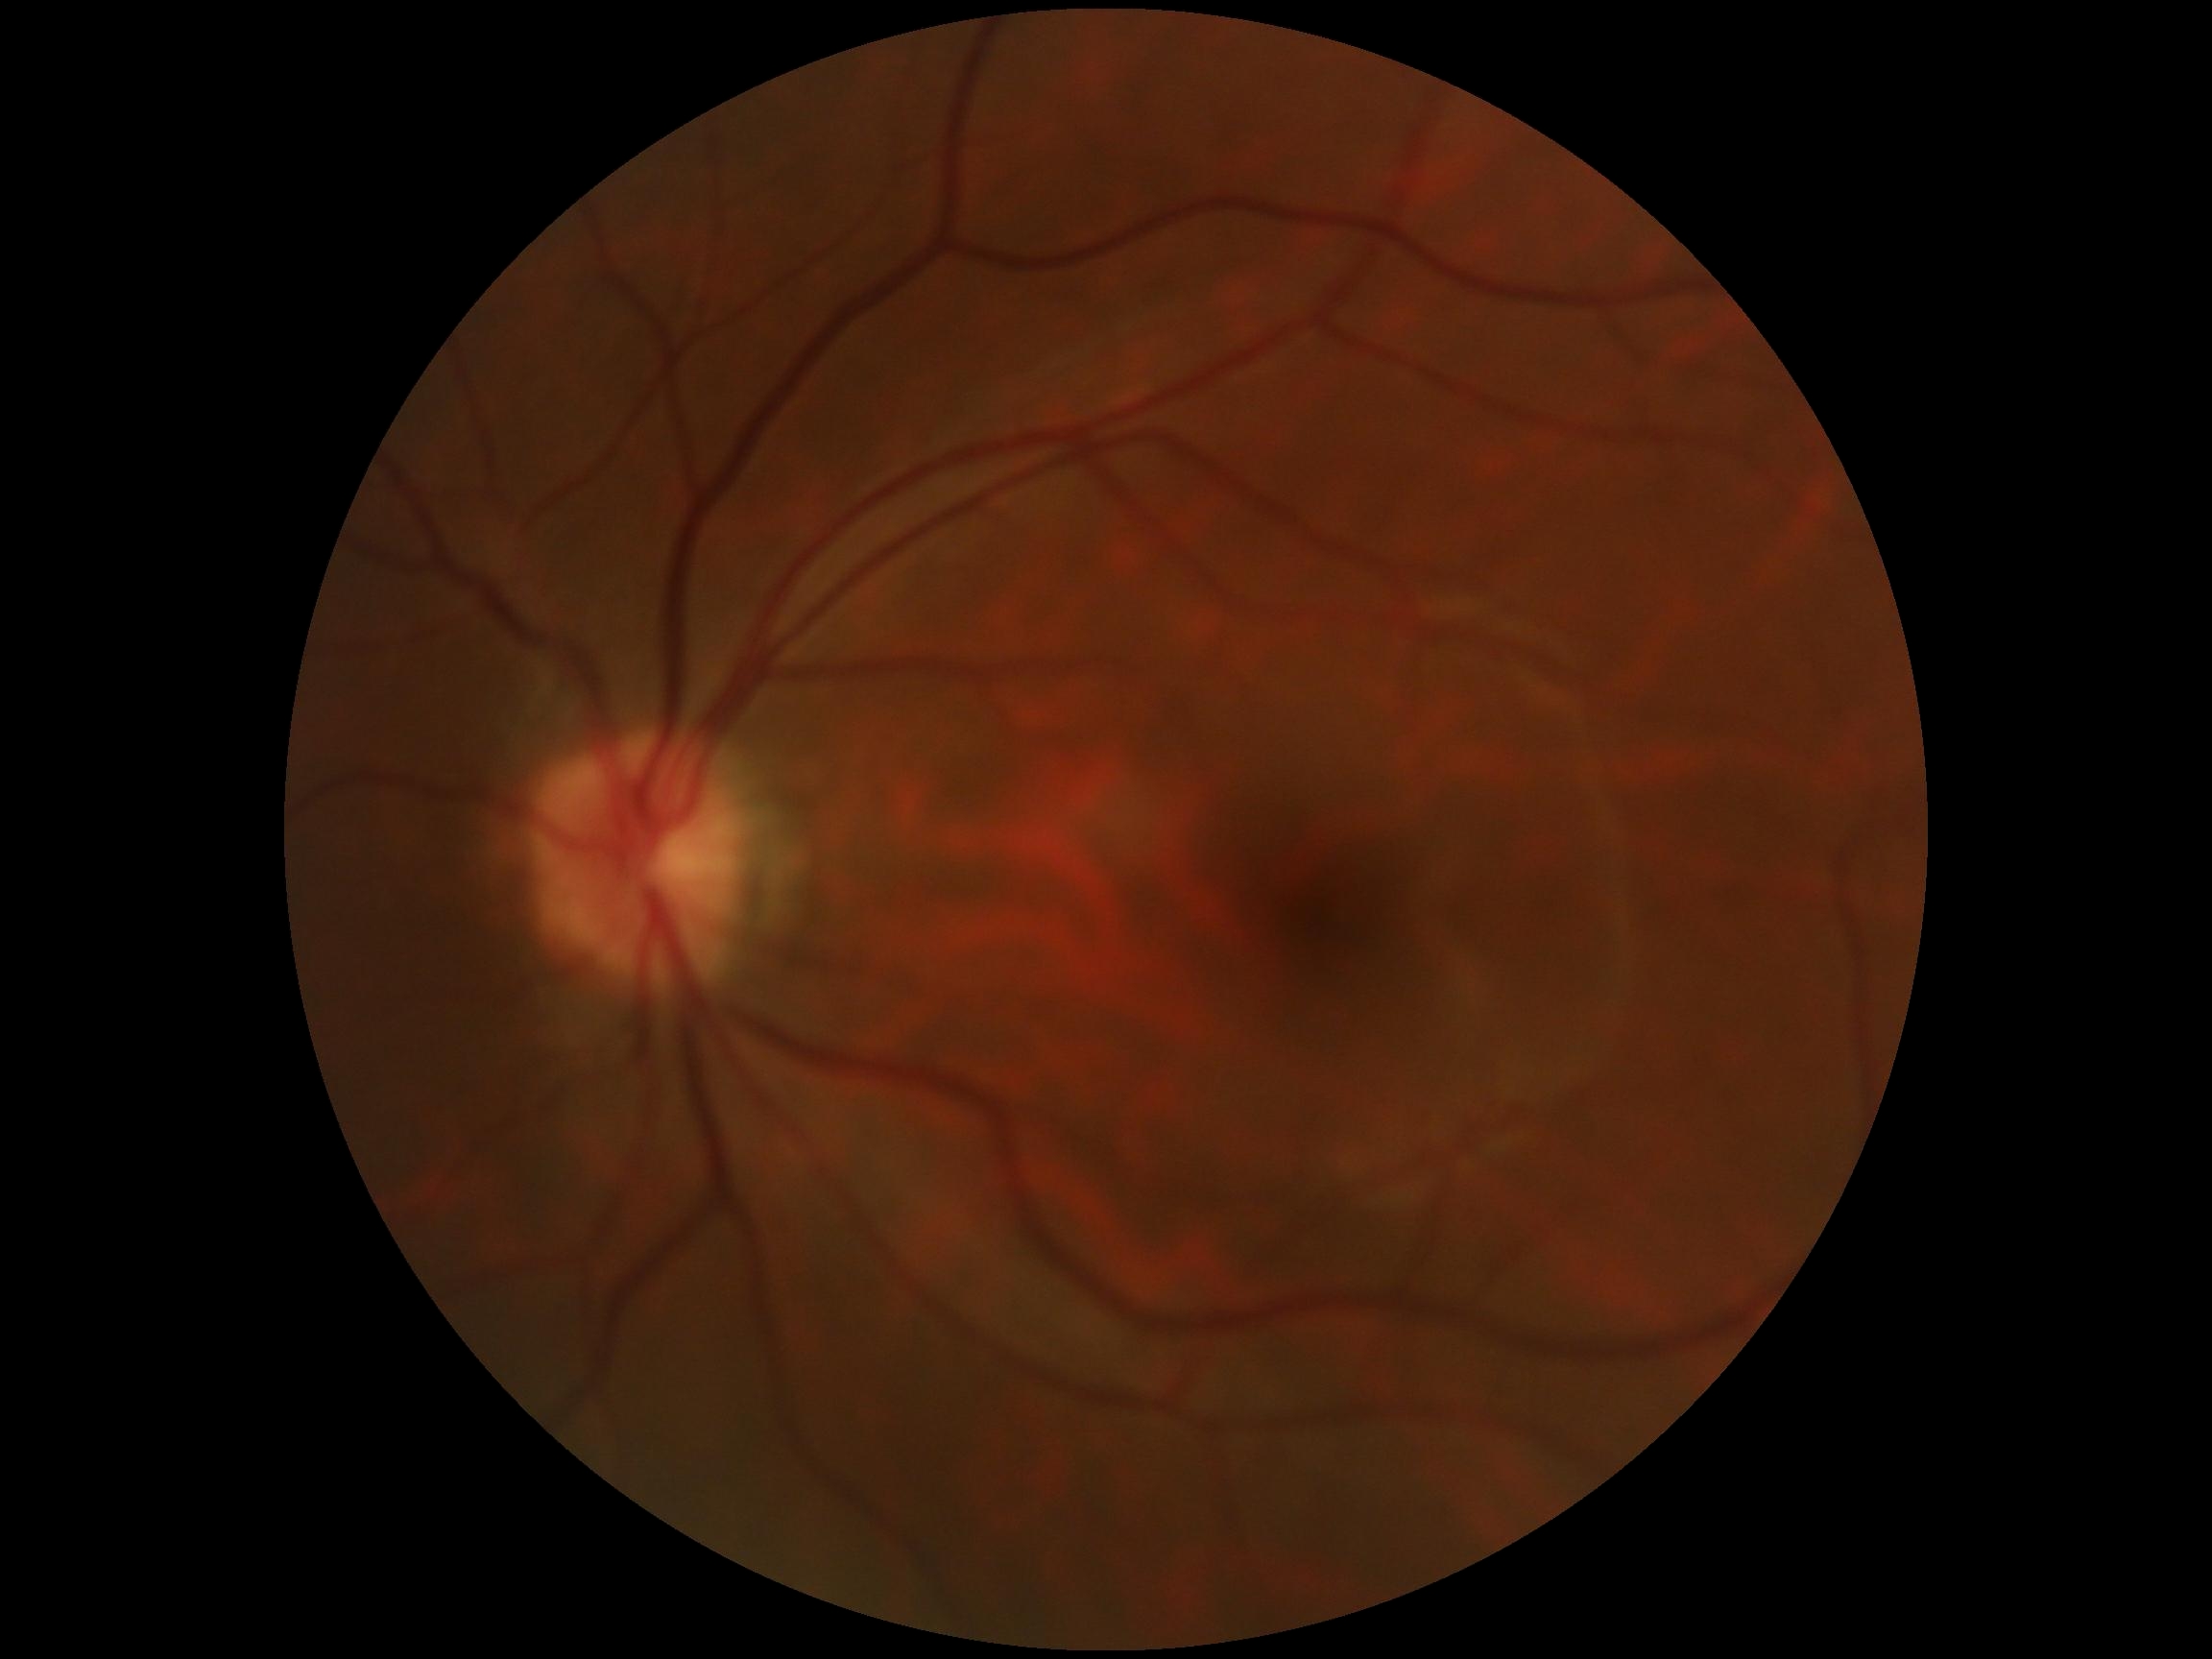

DR stage: no apparent retinopathy (grade 0).